Infant wide-field retinal image — 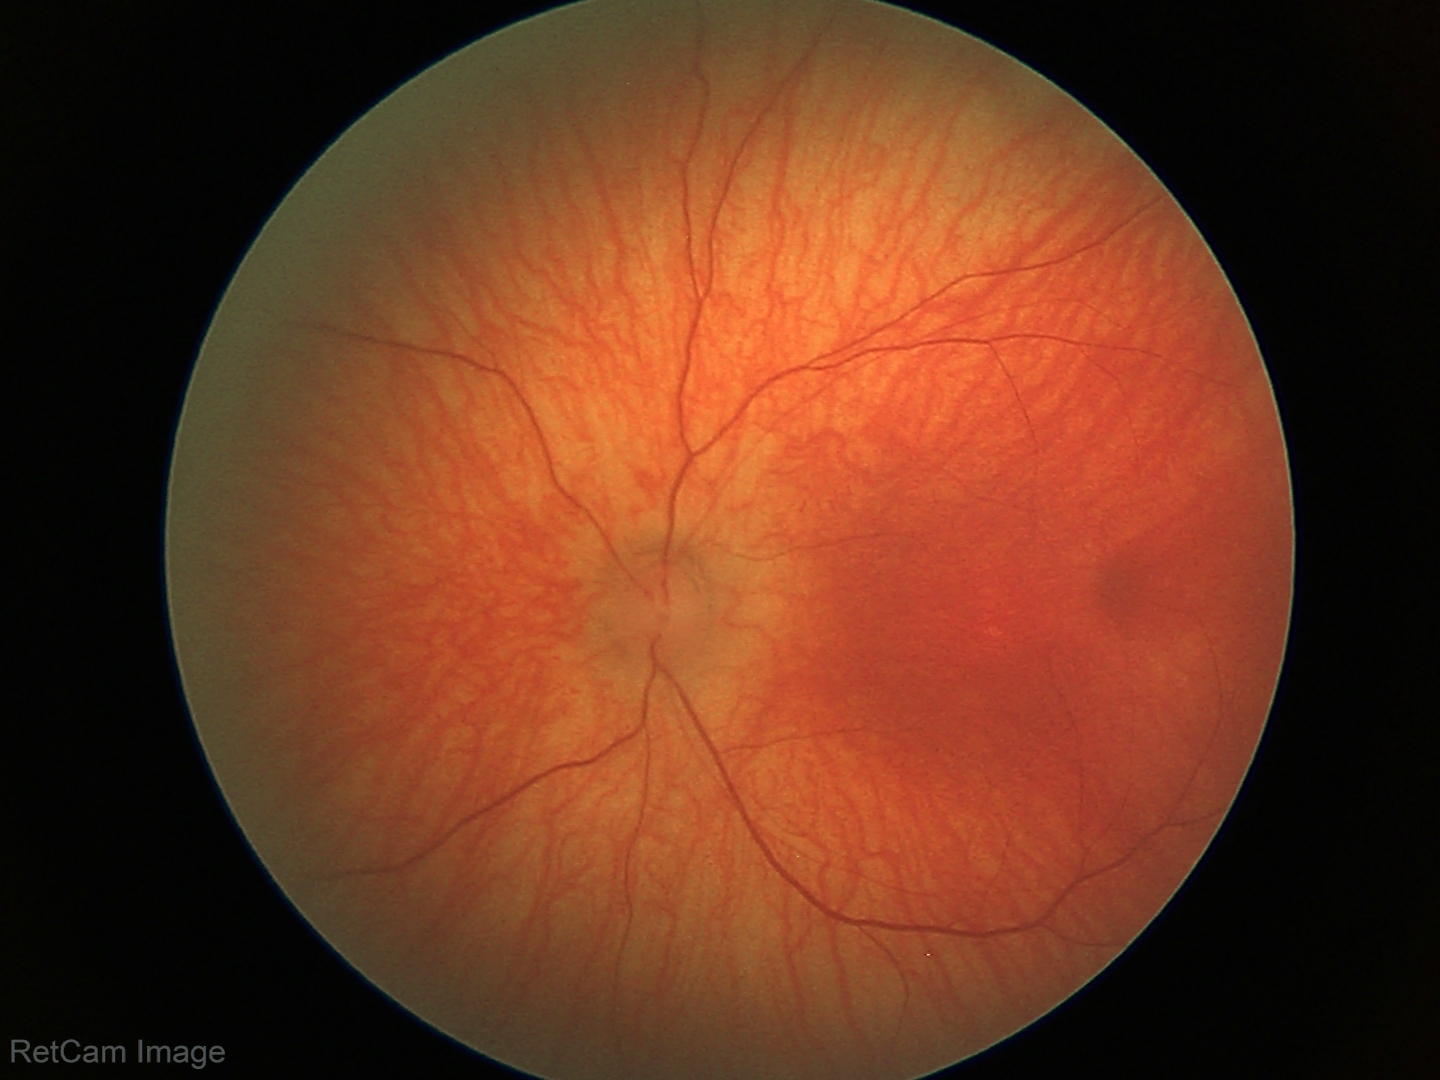 Examination with physiological retinal findings.